640 x 480 pixels · wide-field fundus photograph of an infant · acquired on the Clarity RetCam 3
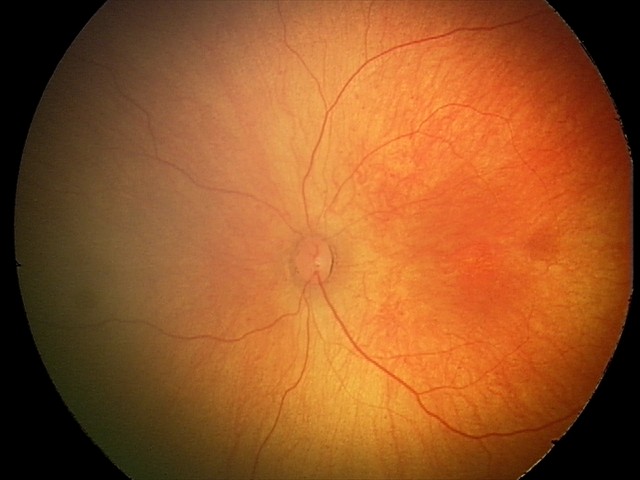
Examination with physiological retinal findings.